130° field of view (Natus RetCam Envision) · 1440x1080px · RetCam wide-field infant fundus image.
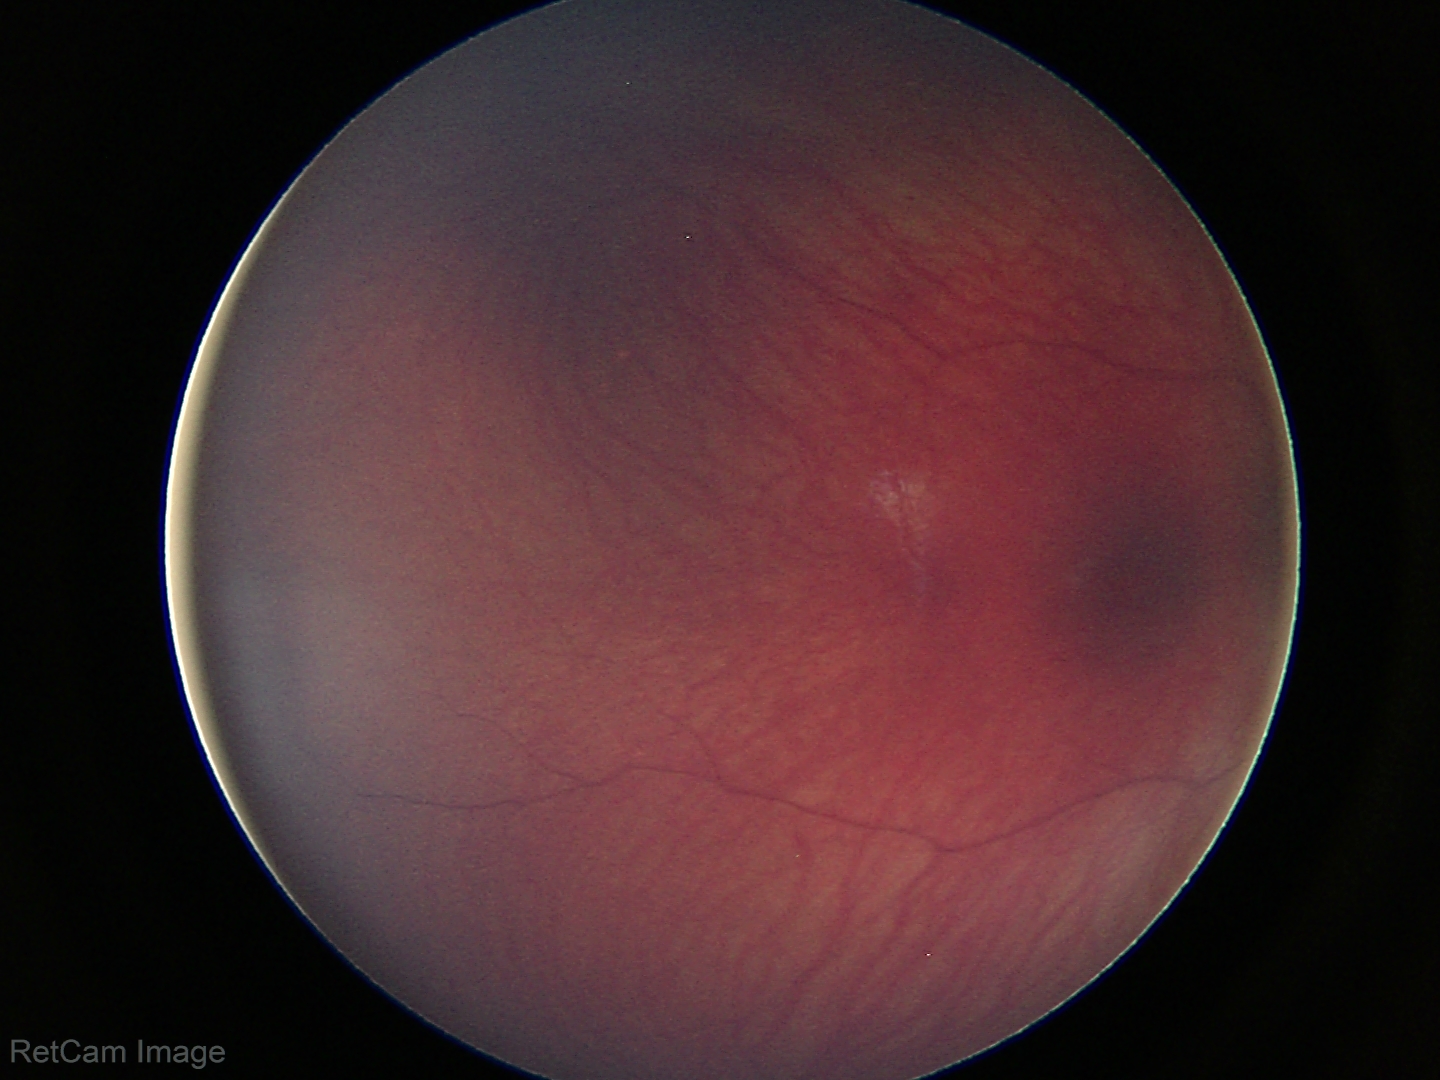

Screening examination with no abnormal retinal findings.